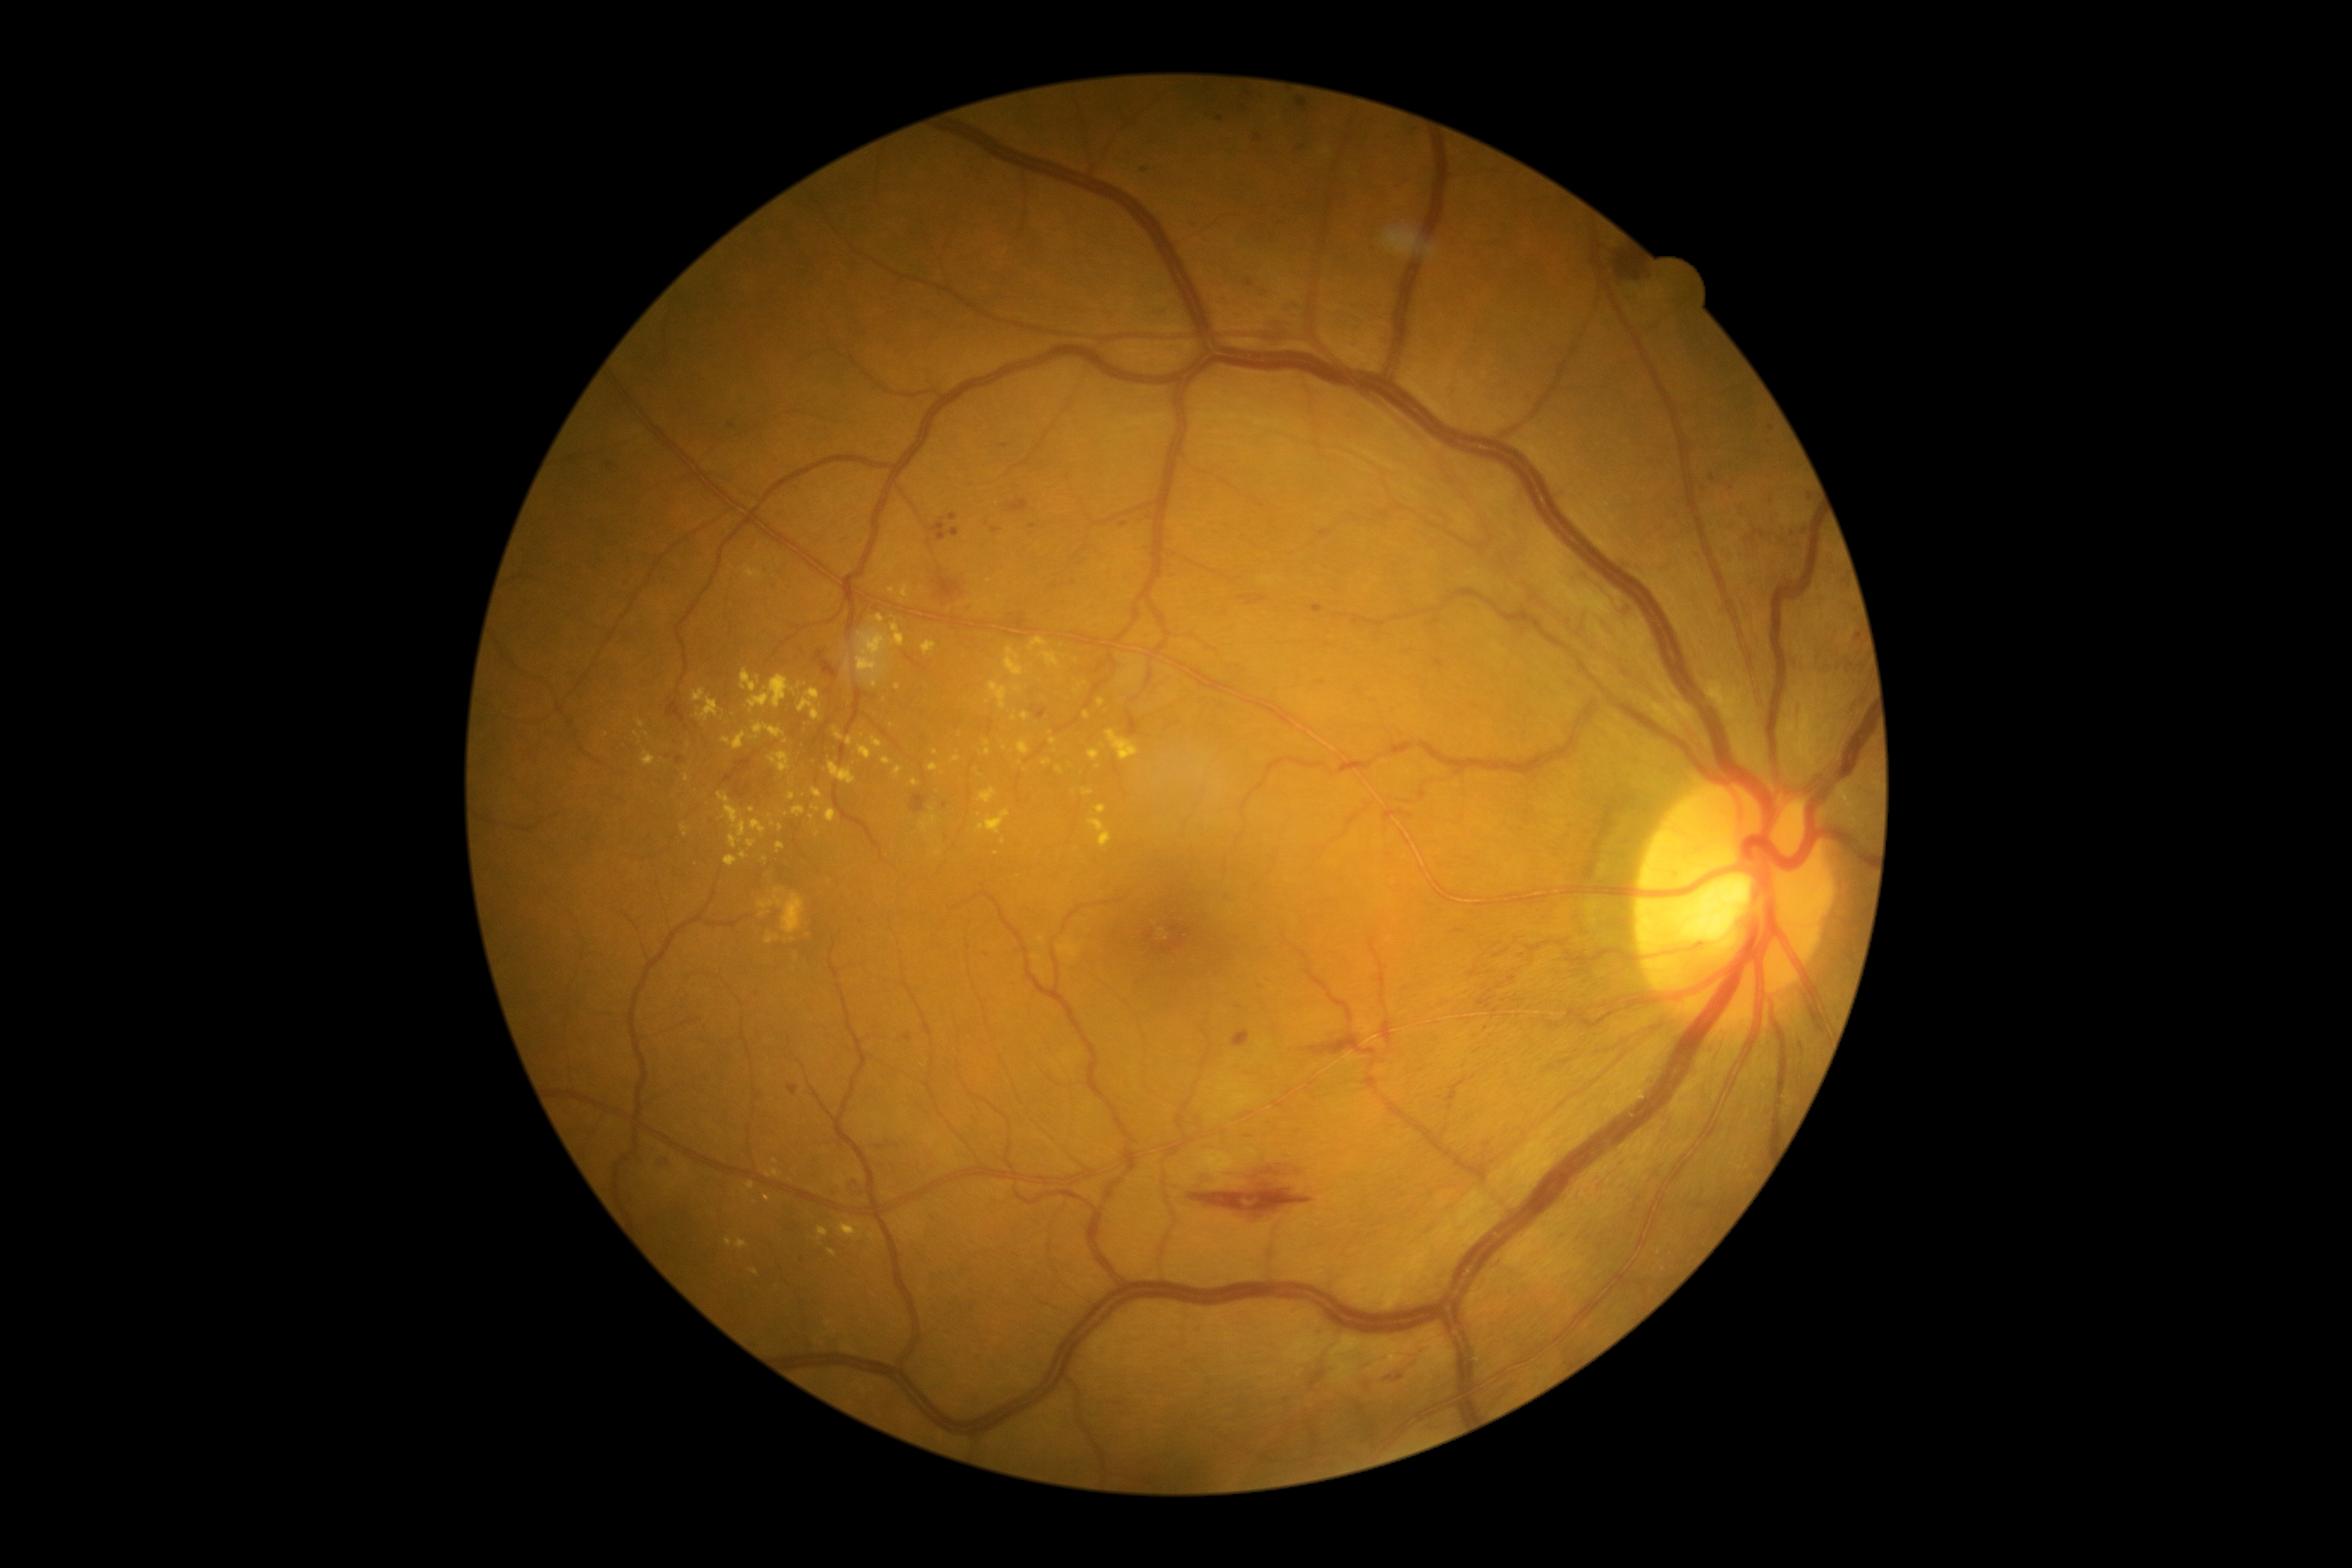
Diabetic retinopathy severity is moderate NPDR (grade 2)
Lesions identified (partial list):
hard exudates (more not shown): (929, 816, 938, 824); (1087, 819, 1112, 848); (895, 548, 907, 553); (721, 732, 747, 750); (718, 792, 747, 848); (871, 737, 883, 749); (830, 1249, 836, 1258); (979, 788, 998, 804); (893, 768, 903, 778); (902, 585, 909, 599); (845, 661, 850, 671); (1019, 740, 1031, 756)
Additional small hard exudates near [x=1077, y=661]; [x=1132, y=672]; [x=811, y=817]; [x=988, y=581]; [x=817, y=834]; [x=1060, y=771]; [x=780, y=827]